Retinal fundus photograph — 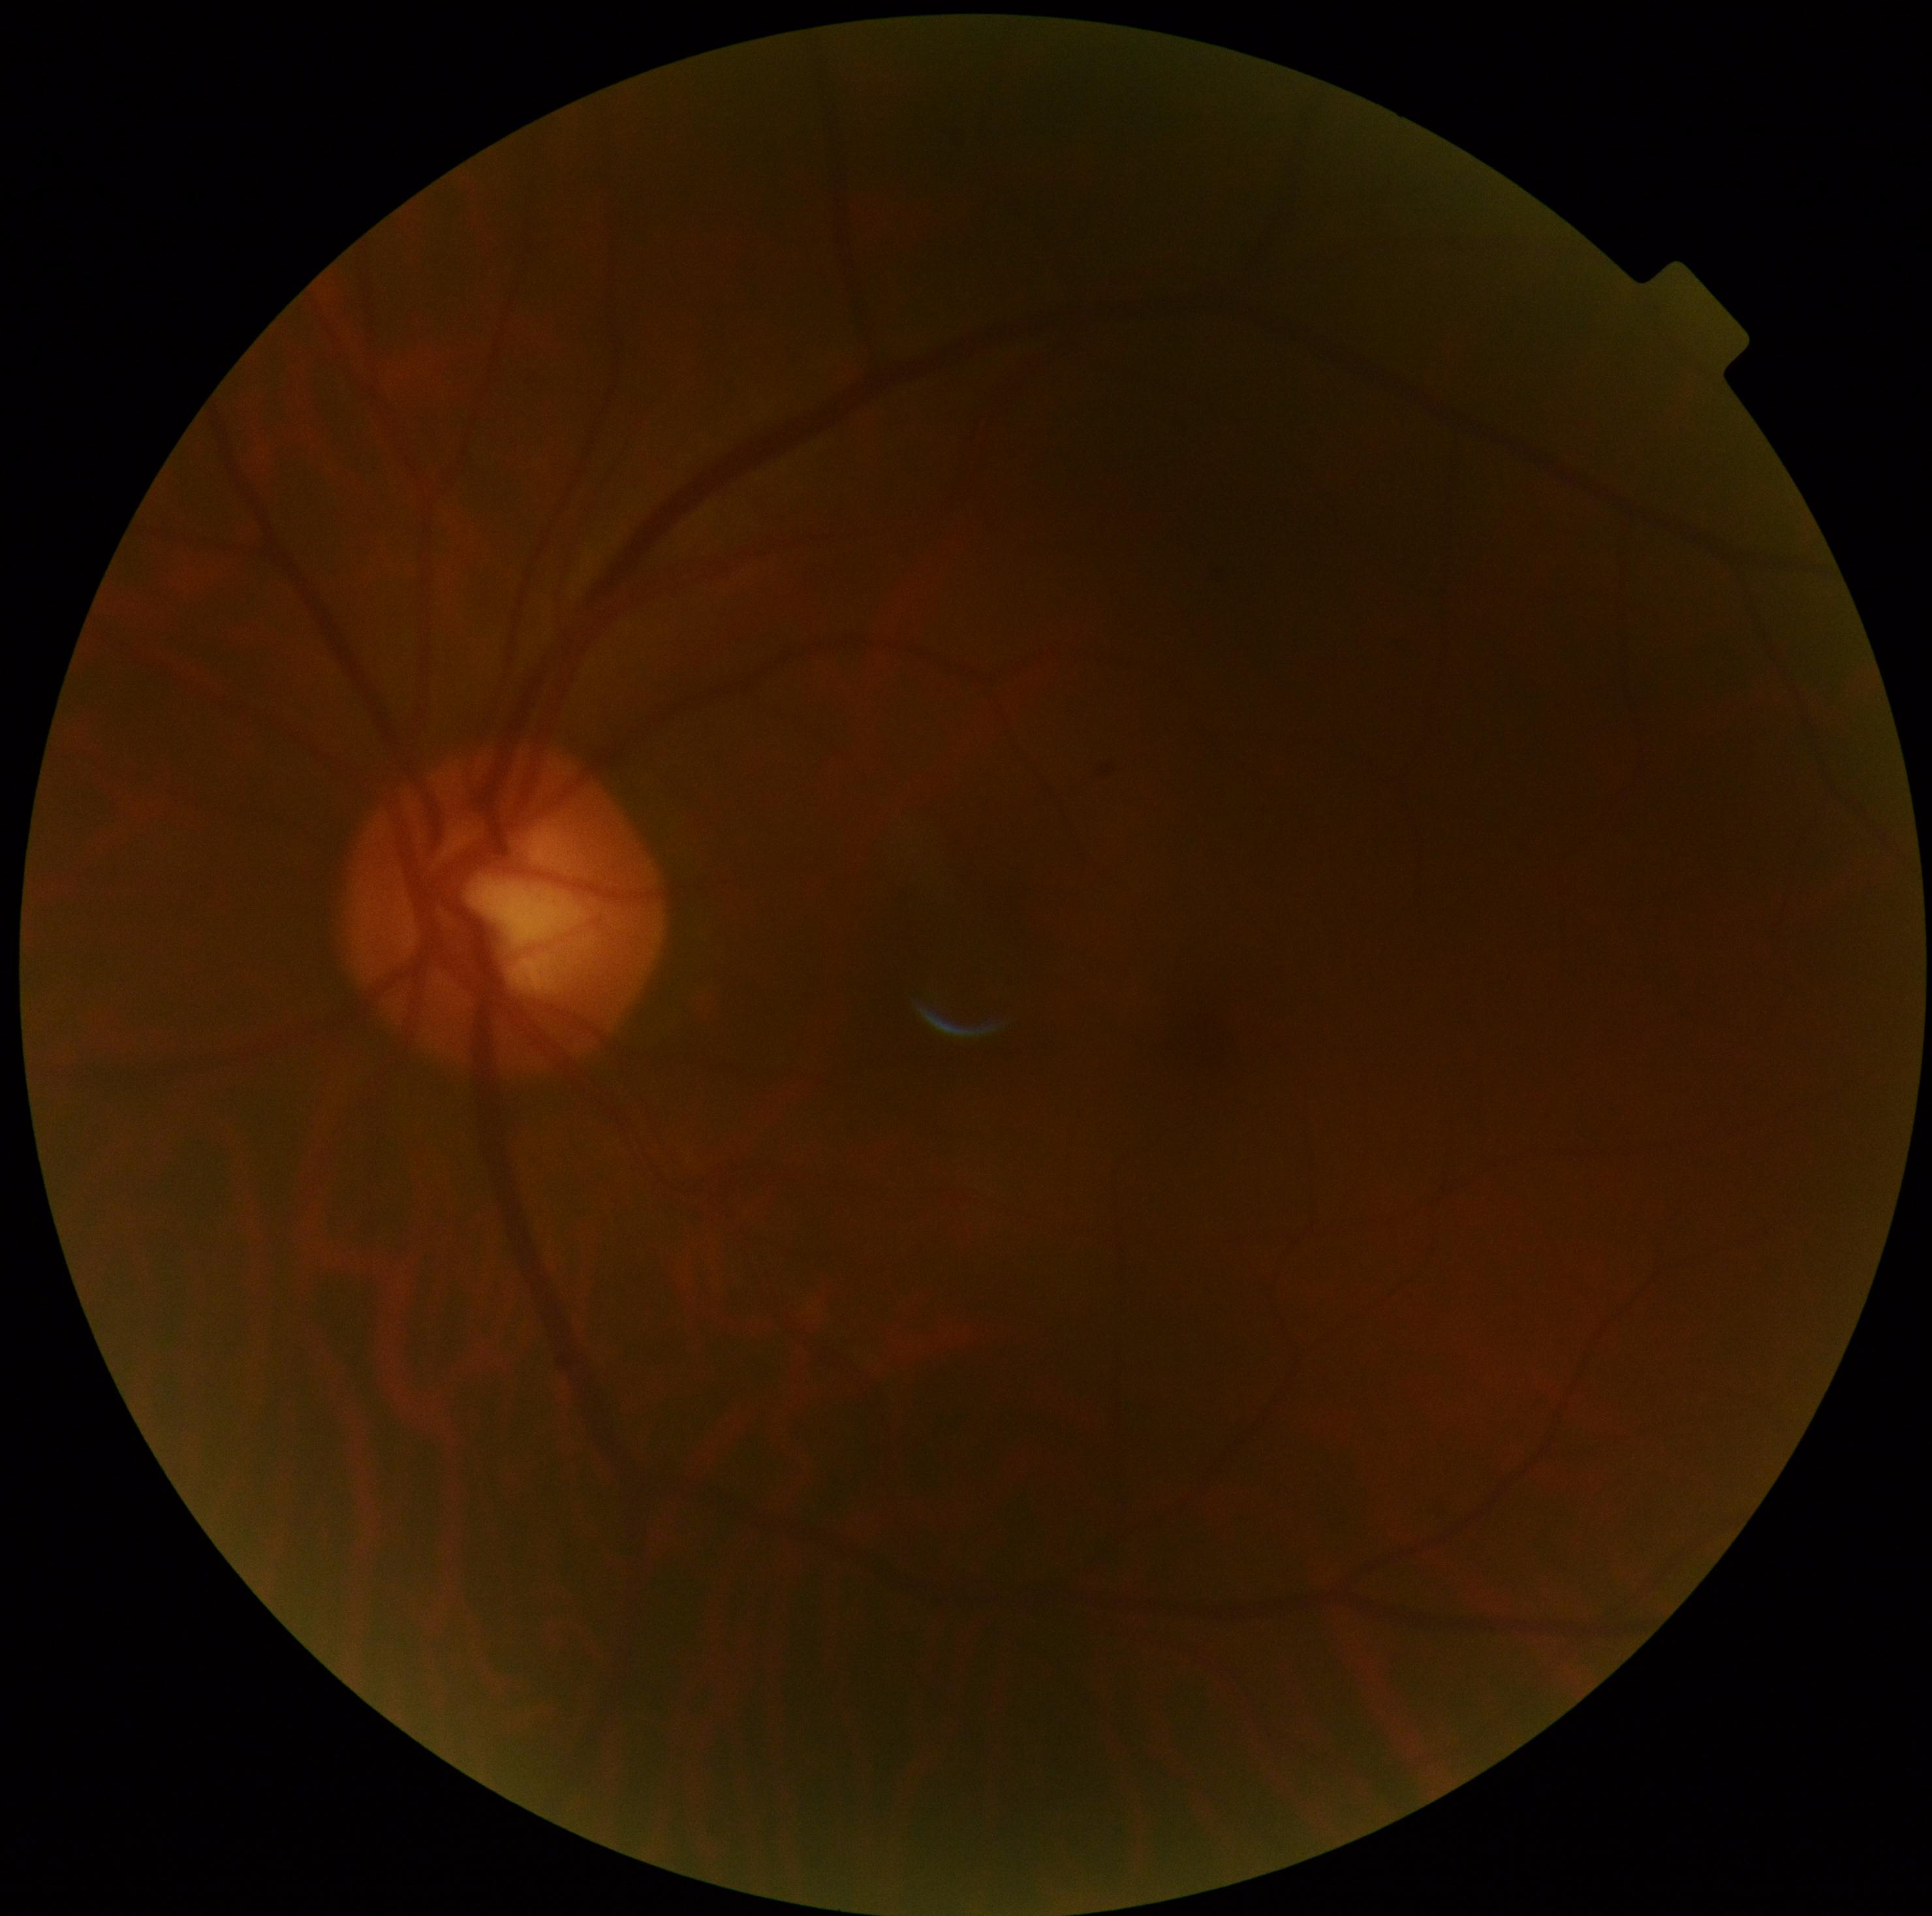 DR is 0.